Image size 2352x1568; fundus photo.
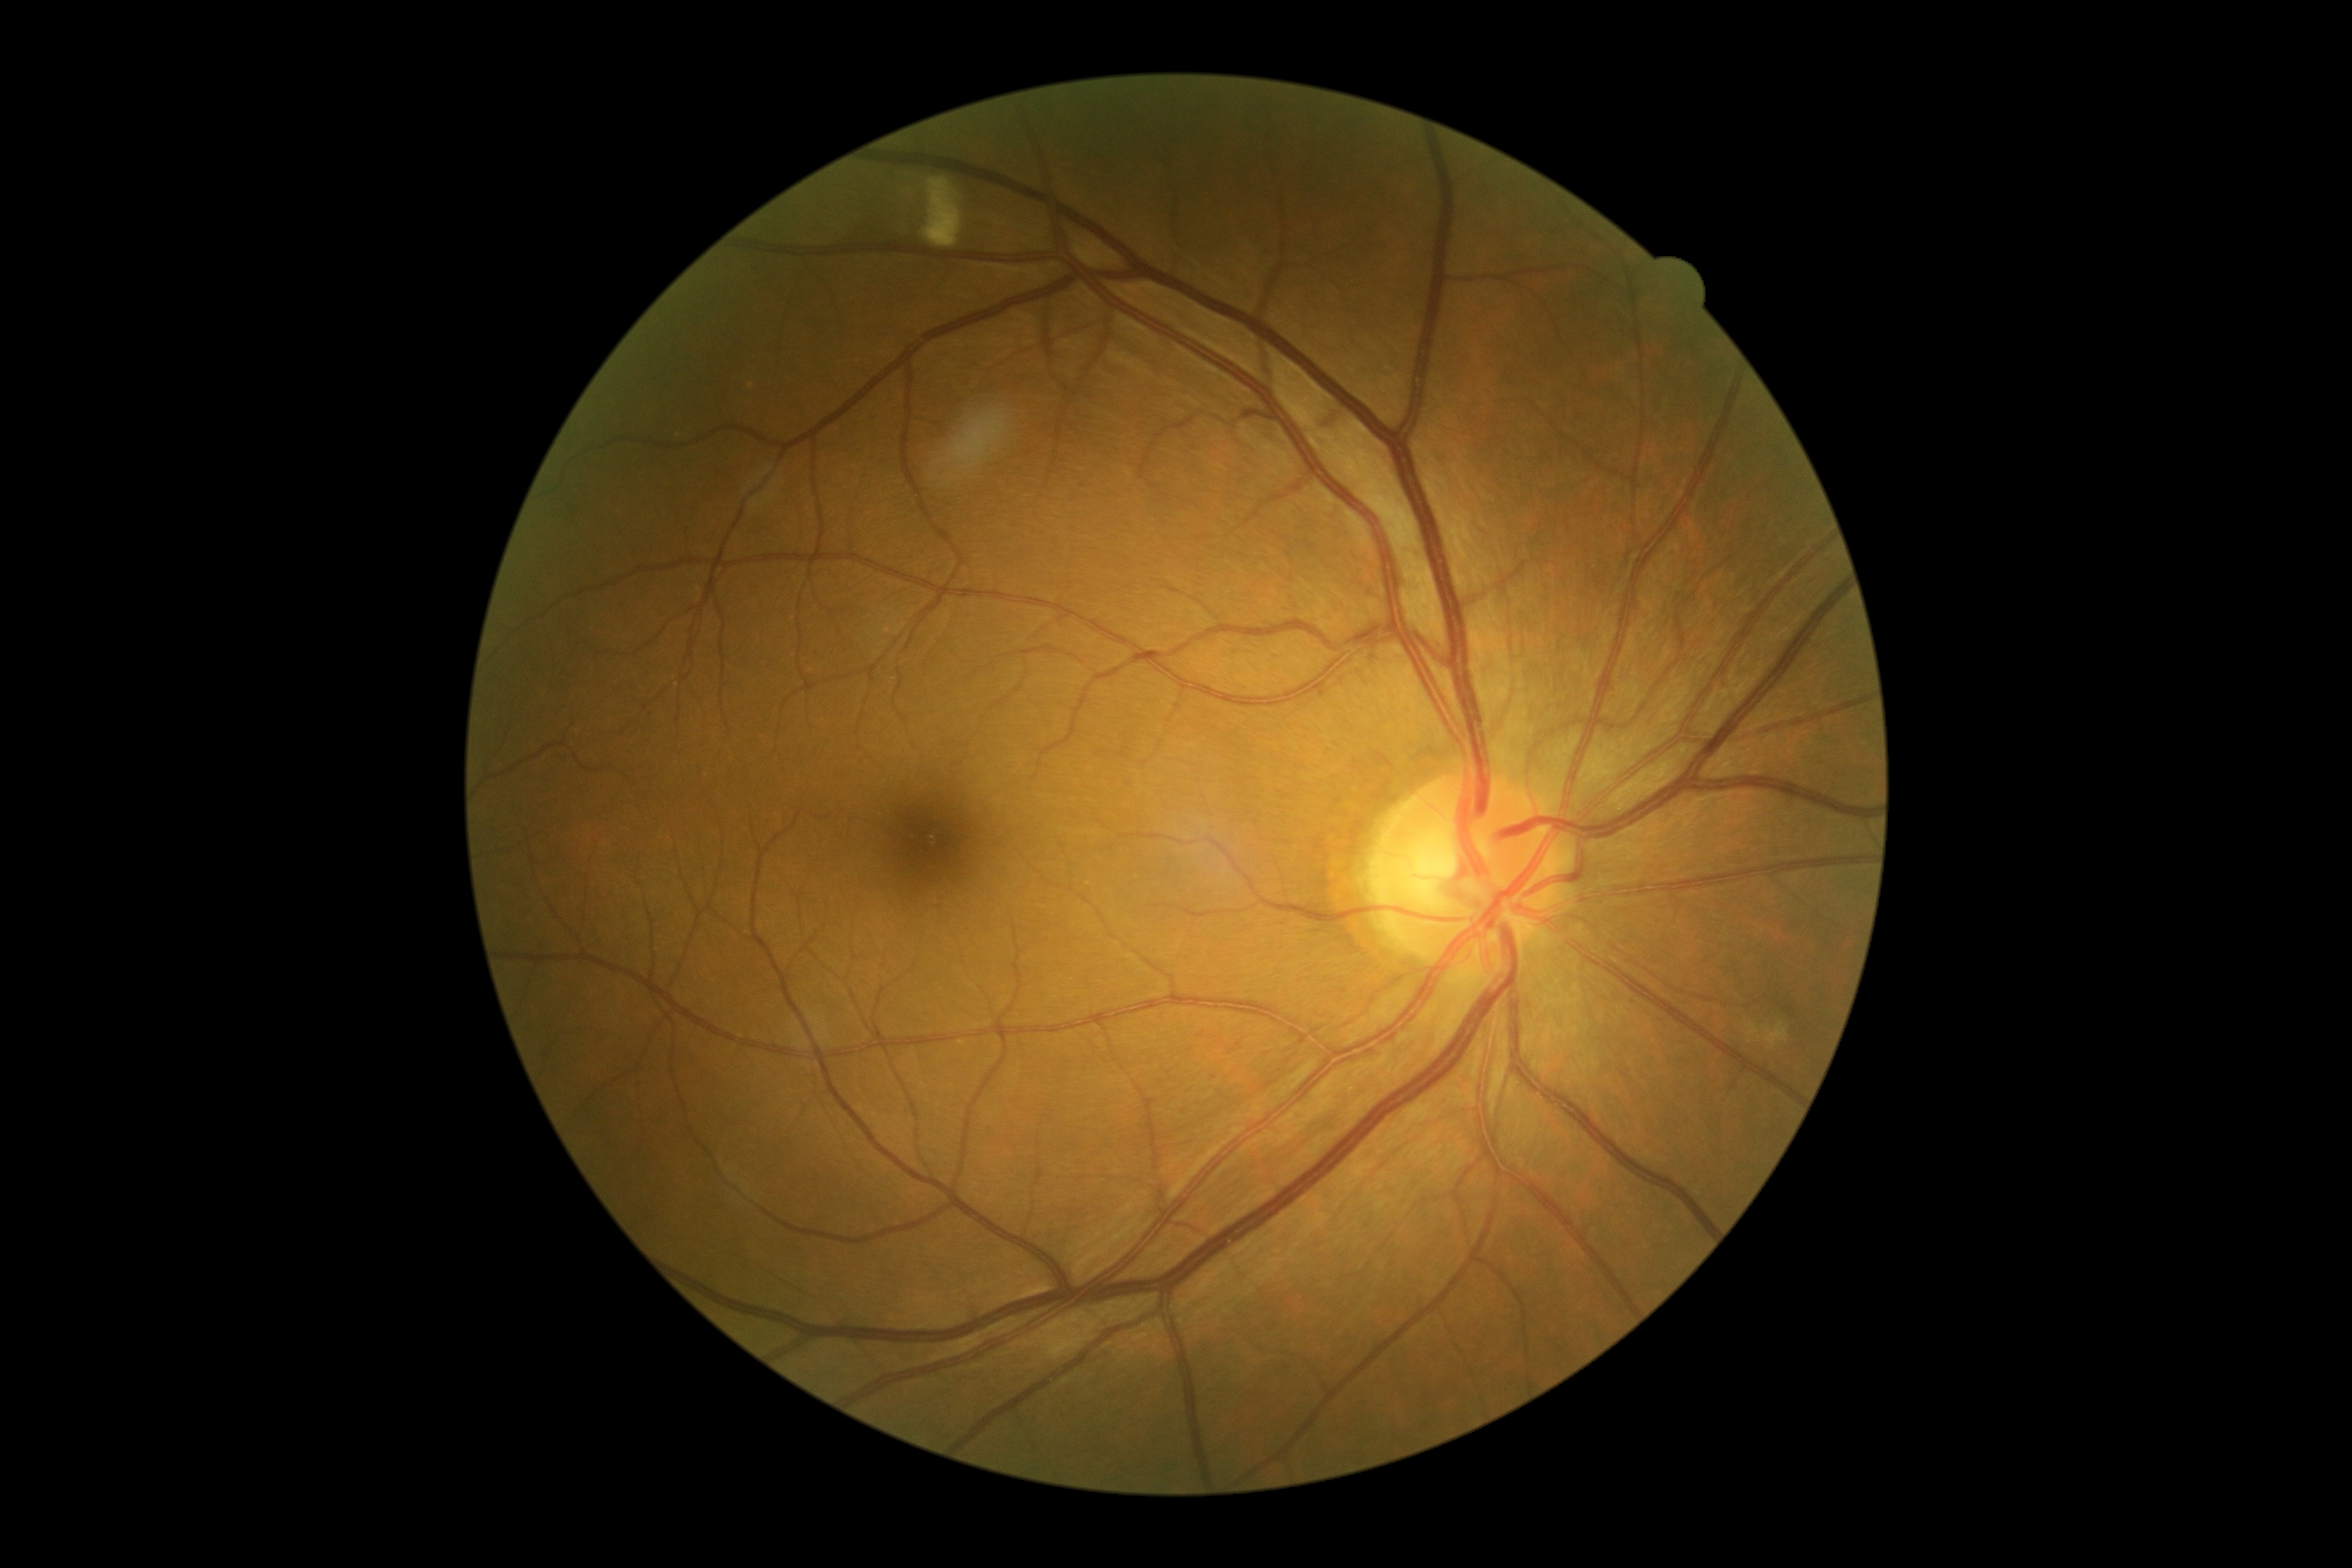

Annotations:
• retinopathy grade: 2